2048 x 1536 pixels.
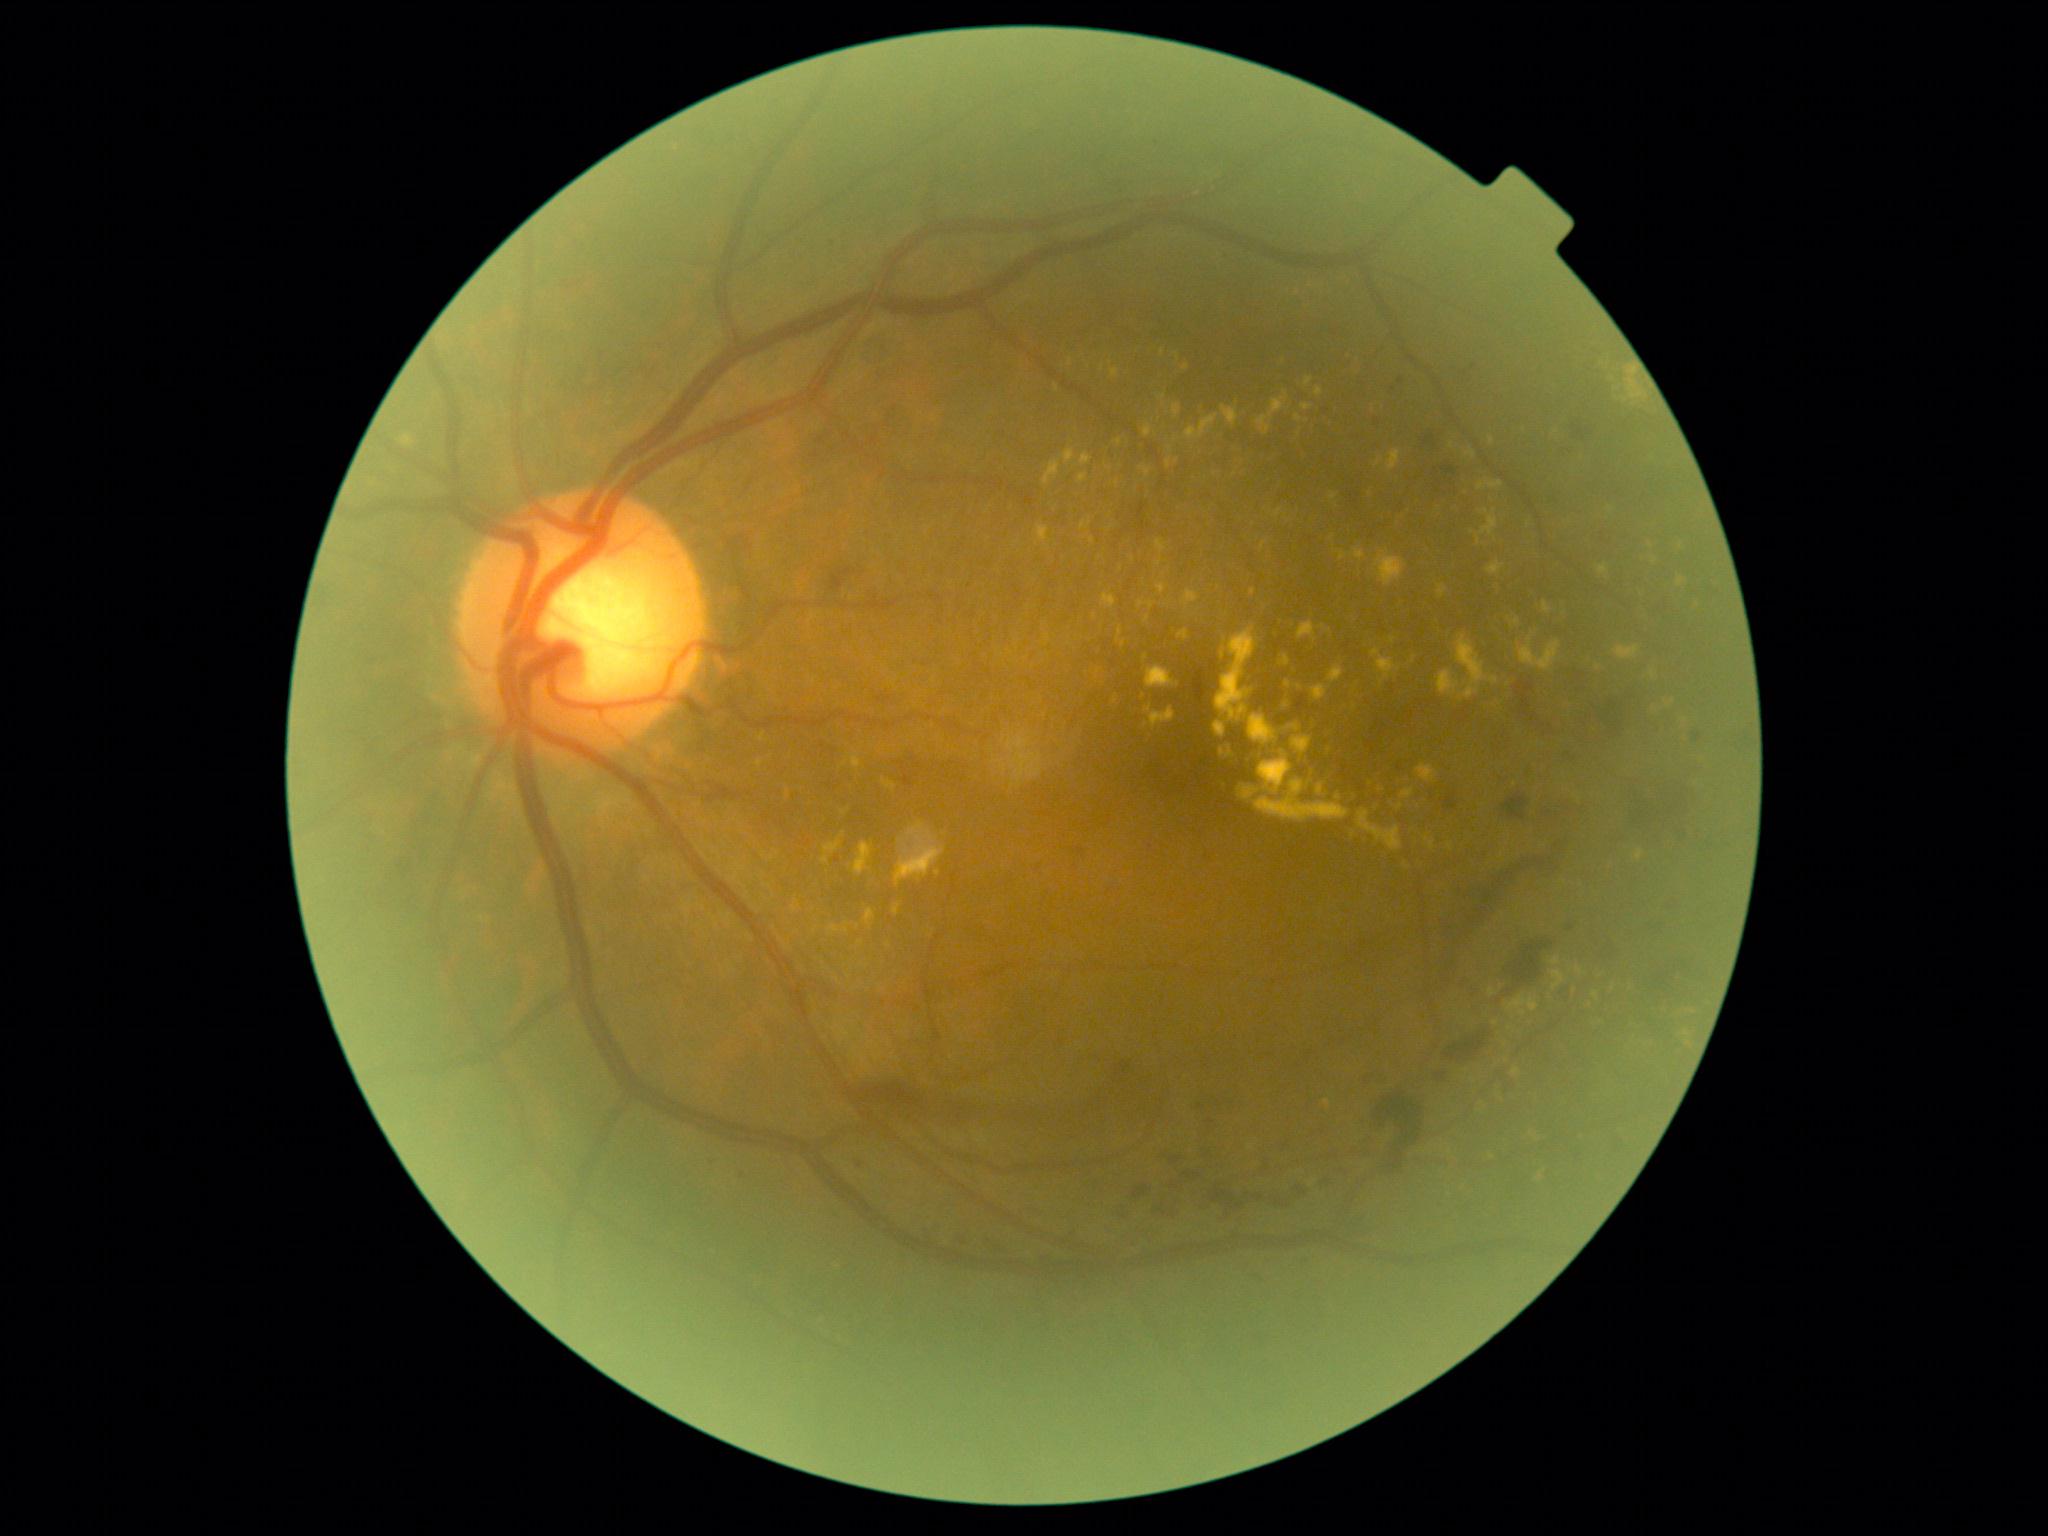 Diabetic retinopathy (DR): grade 2 (moderate NPDR)
Selected lesions:
hard exudates (EXs) (partial): 1488:437:1495:447; 1628:380:1644:400; 854:842:873:876; 1261:542:1267:552; 864:909:876:928; 1543:601:1552:614; 1257:390:1289:437; 1157:584:1166:594; 1045:634:1050:642; 1156:539:1166:554; 1329:493:1338:502; 1166:460:1172:468
Small EXs approximately at x=1542, y=1174; x=861, y=942; x=1070, y=363; x=1177, y=462; x=1307, y=421; x=1406, y=866